45° field of view — 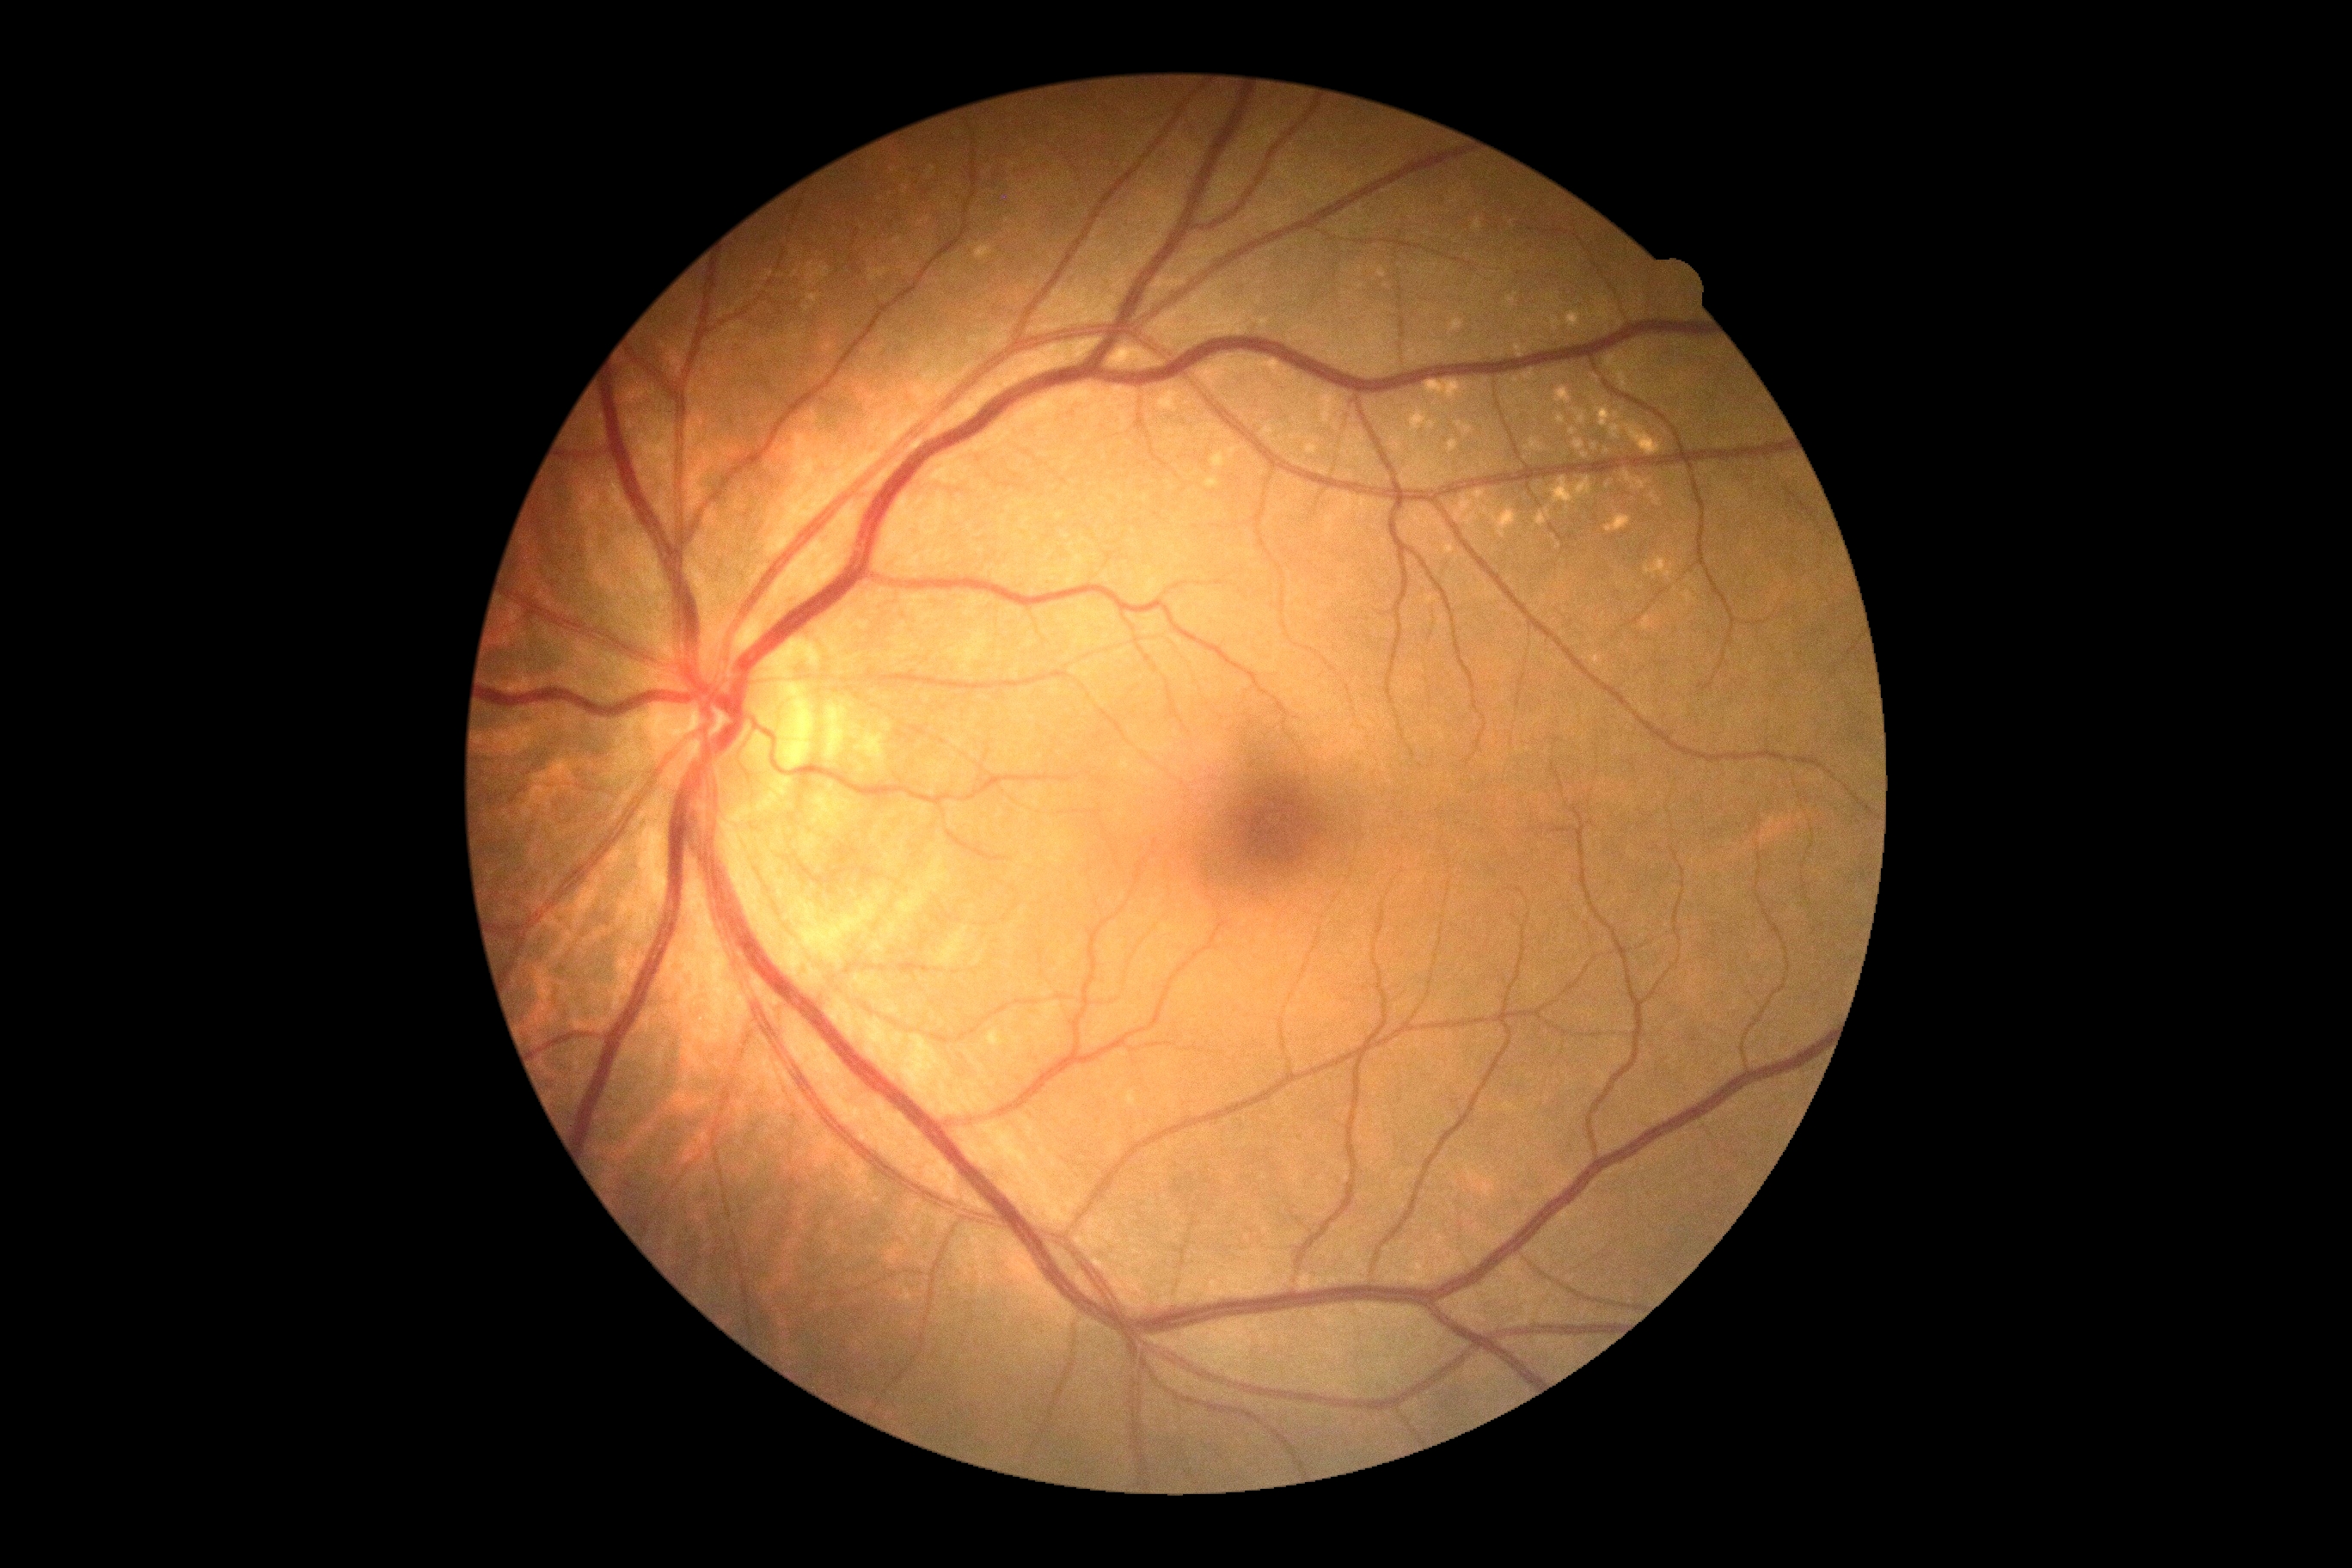 Diabetic retinopathy severity: 0/4.